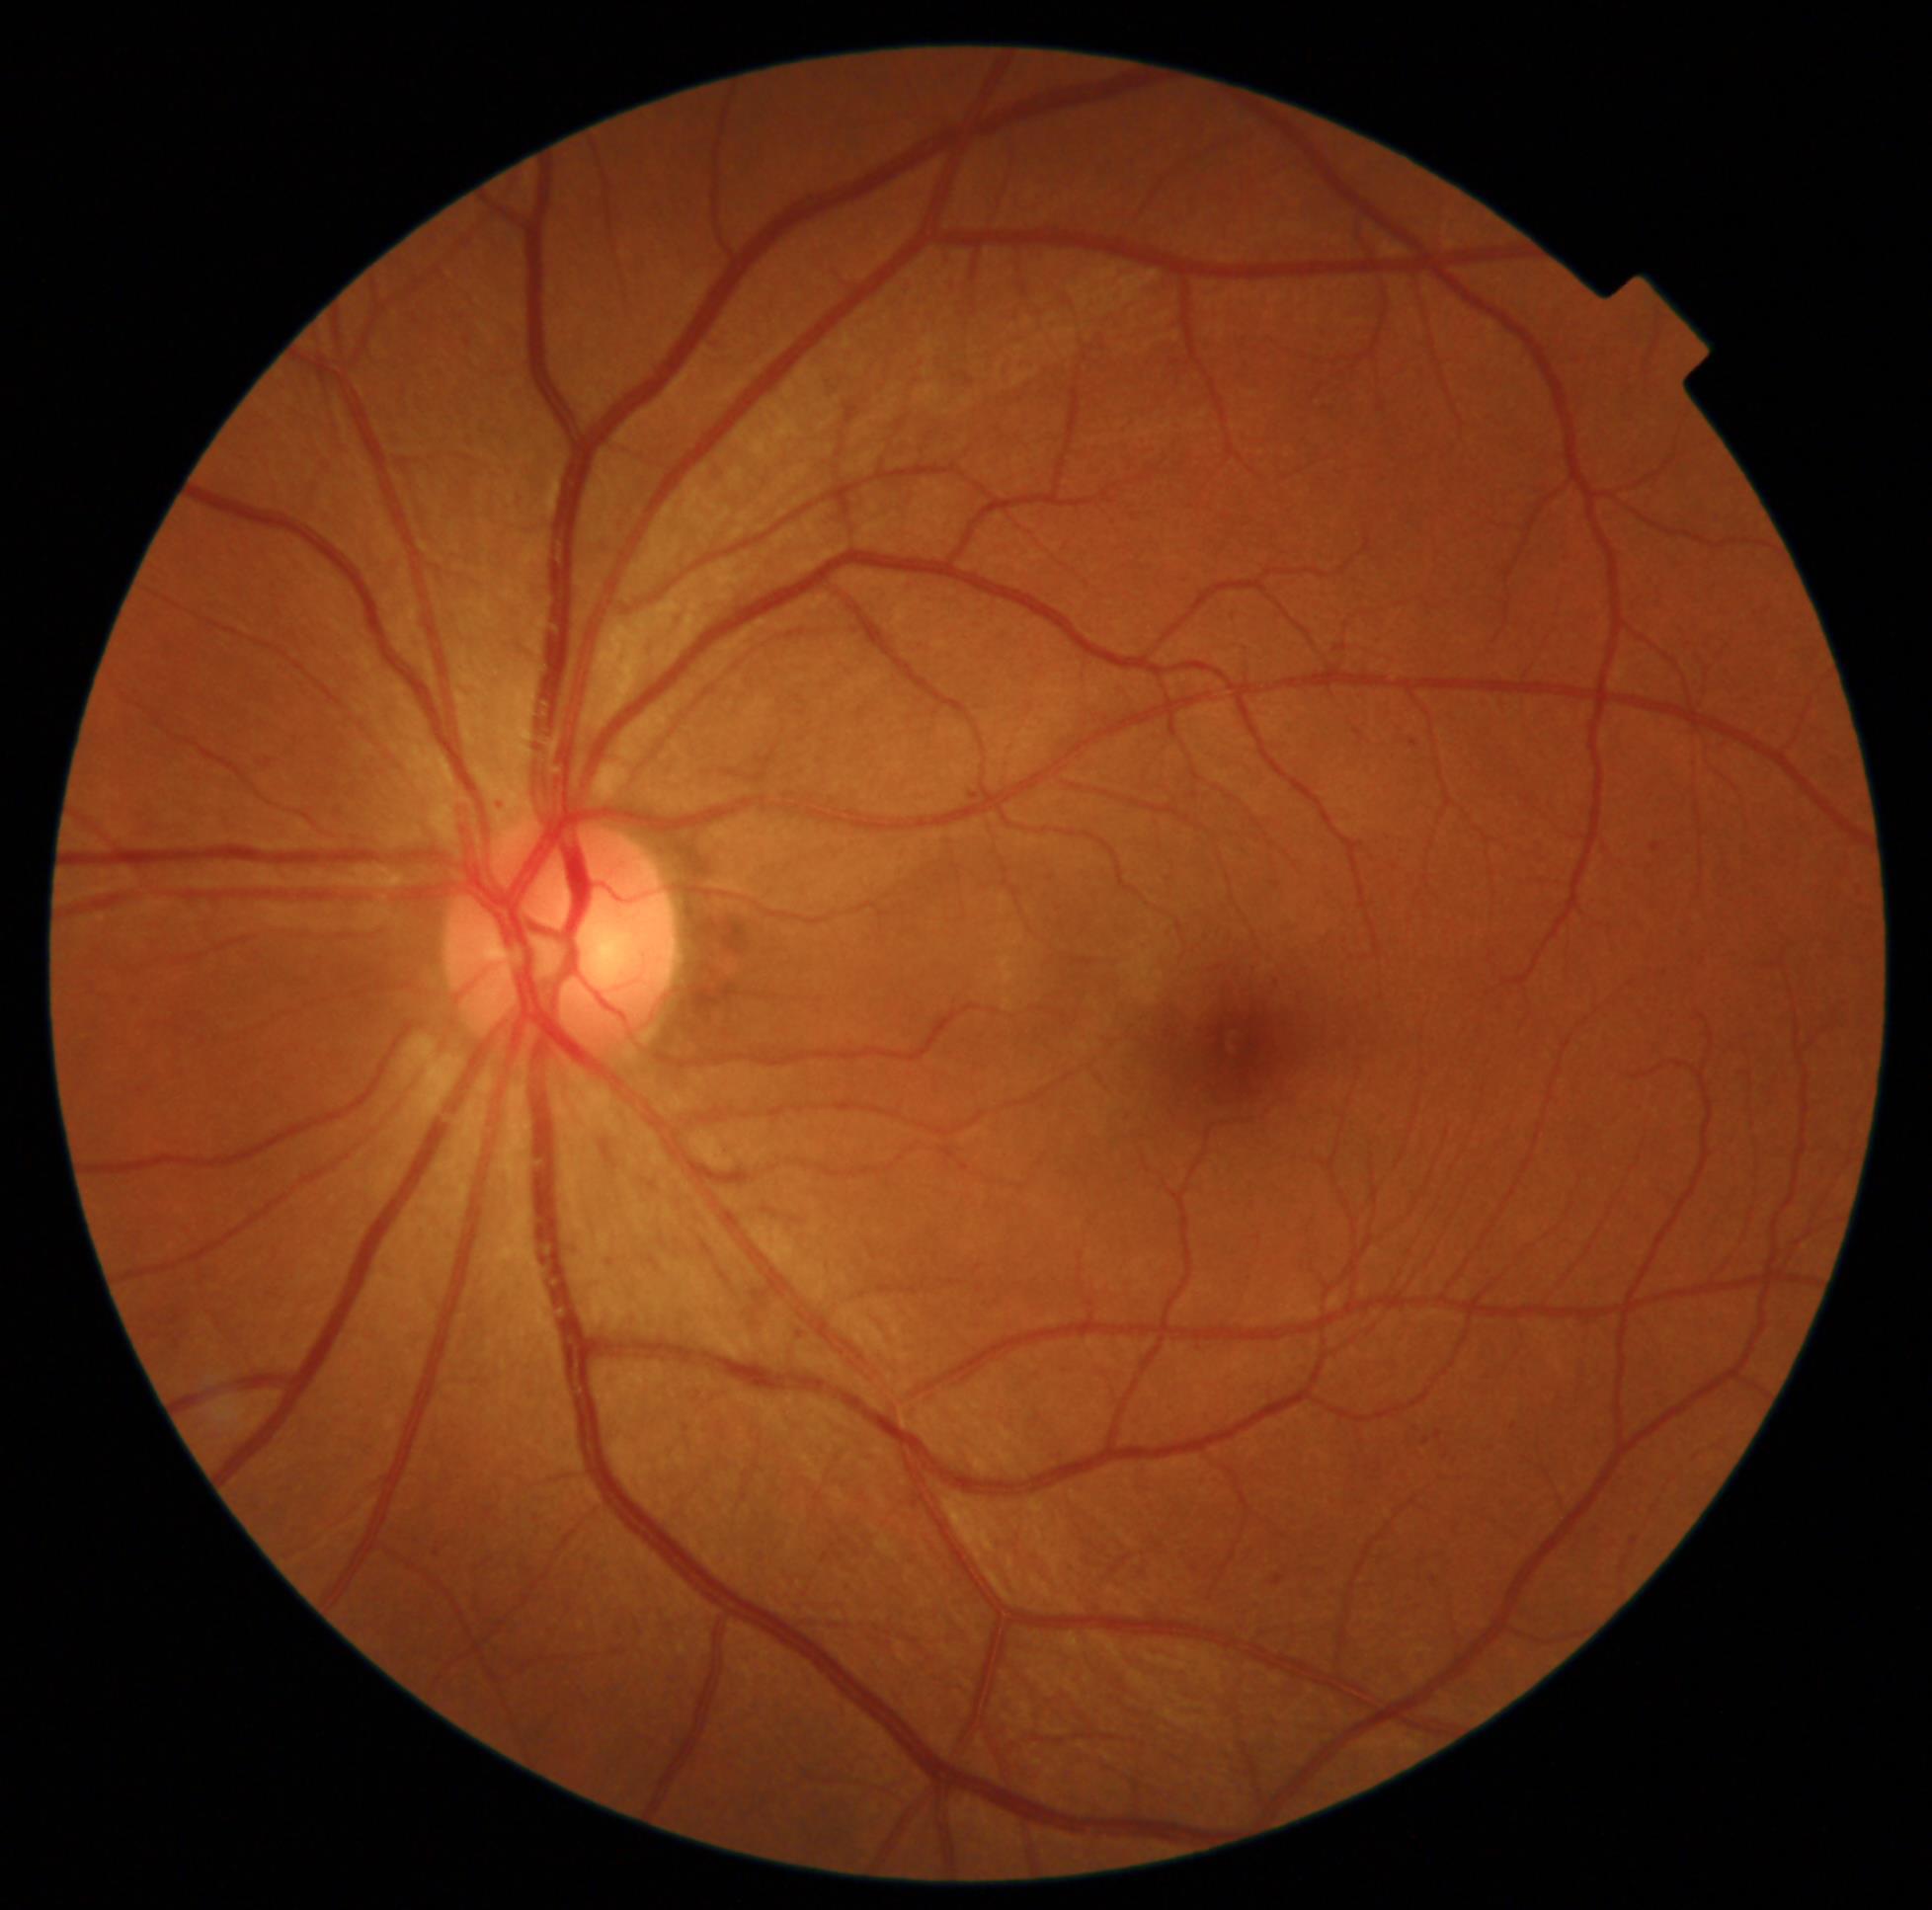 The retinopathy is classified as non-proliferative diabetic retinopathy. DR stage: grade 2 (moderate NPDR) — more than just microaneurysms but less than severe NPDR.